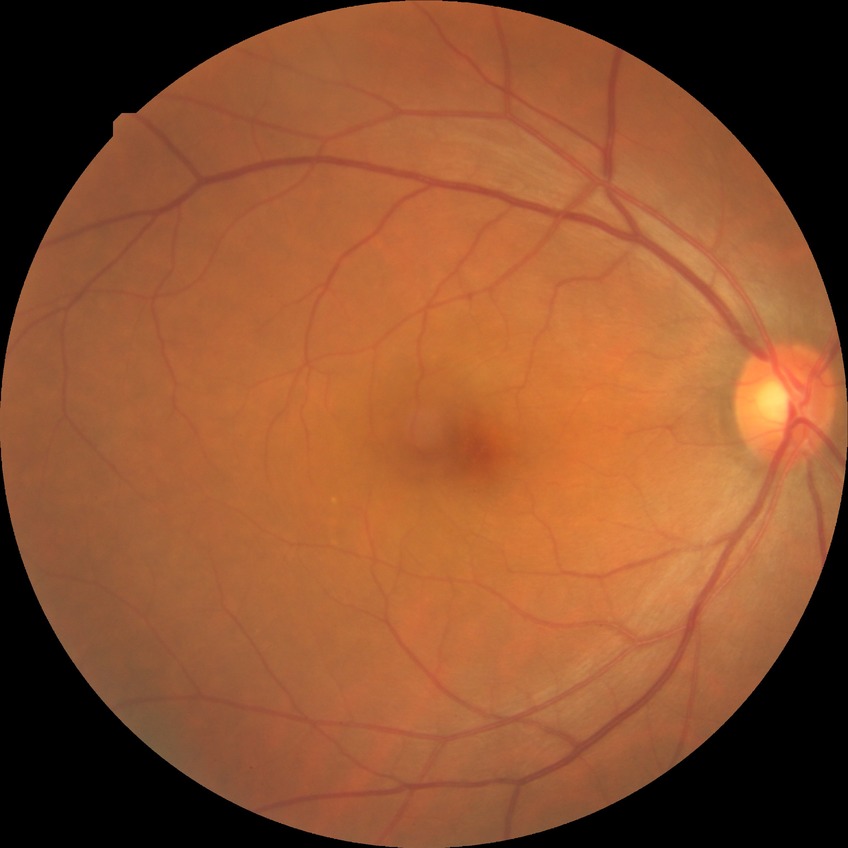
Modified Davis classification is no diabetic retinopathy.